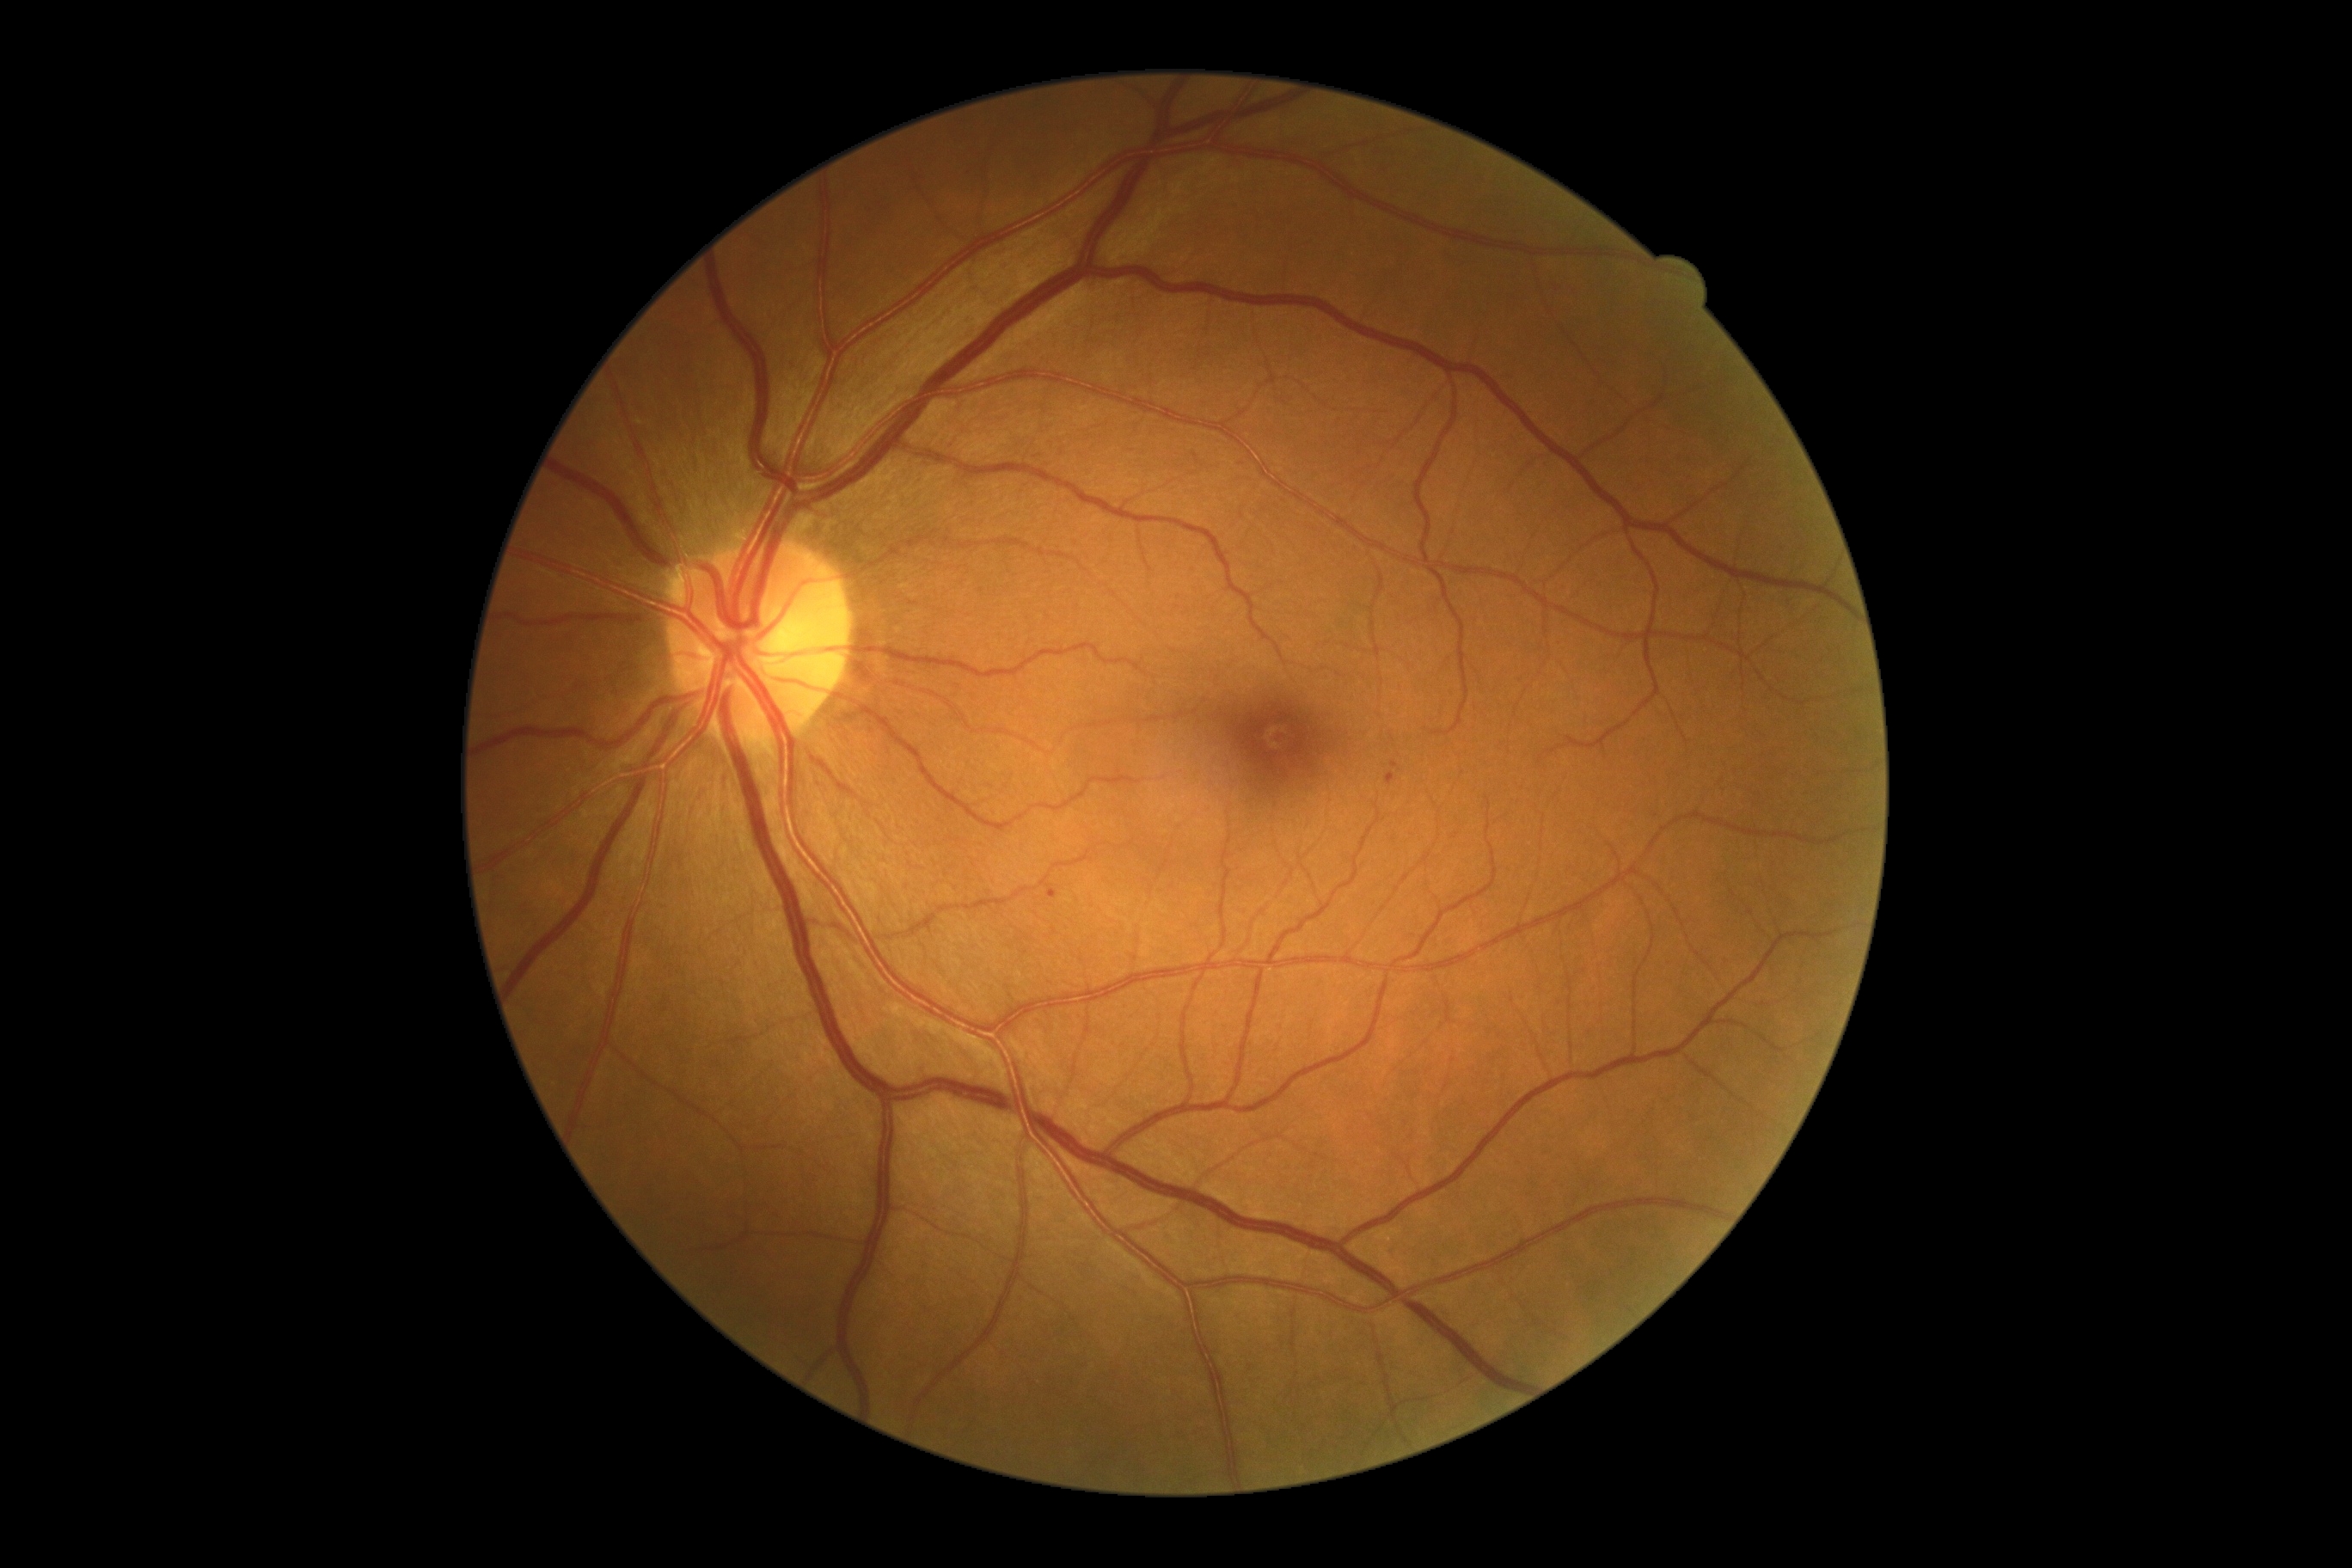 Retinopathy grade: 1 (mild NPDR).
Microaneurysms found at region(1387, 773, 1395, 787); region(1044, 888, 1062, 900).
Small microaneurysms approximately at 1395:764.
No hard exudates identified.
No hemorrhages identified.
No soft exudates identified.